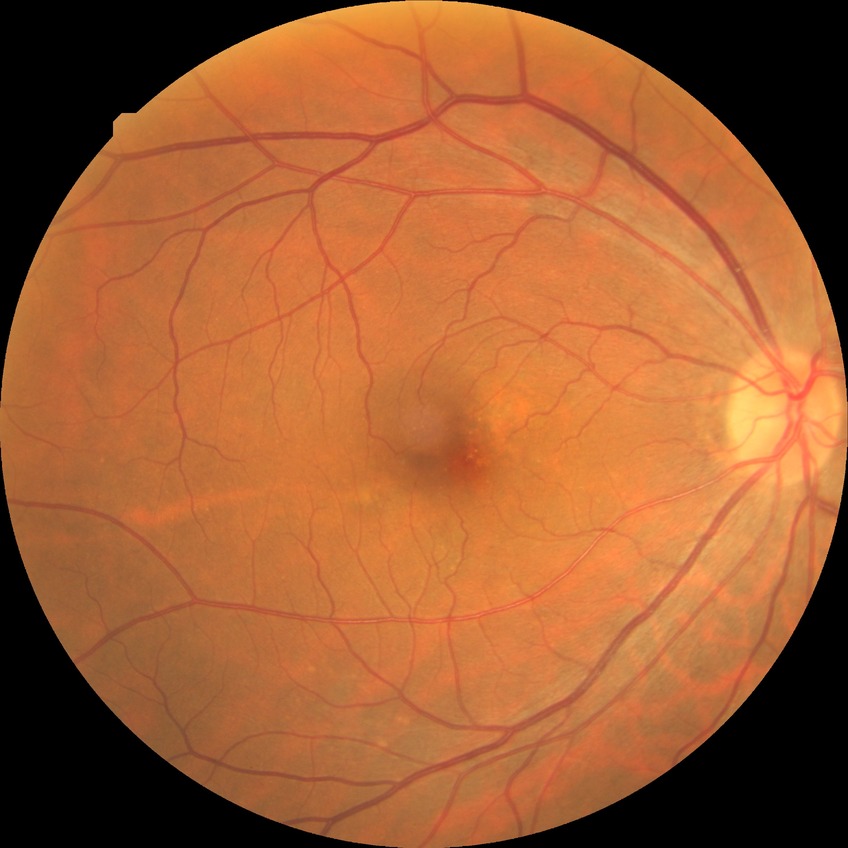

diabetic retinopathy (DR) = no diabetic retinopathy (NDR).